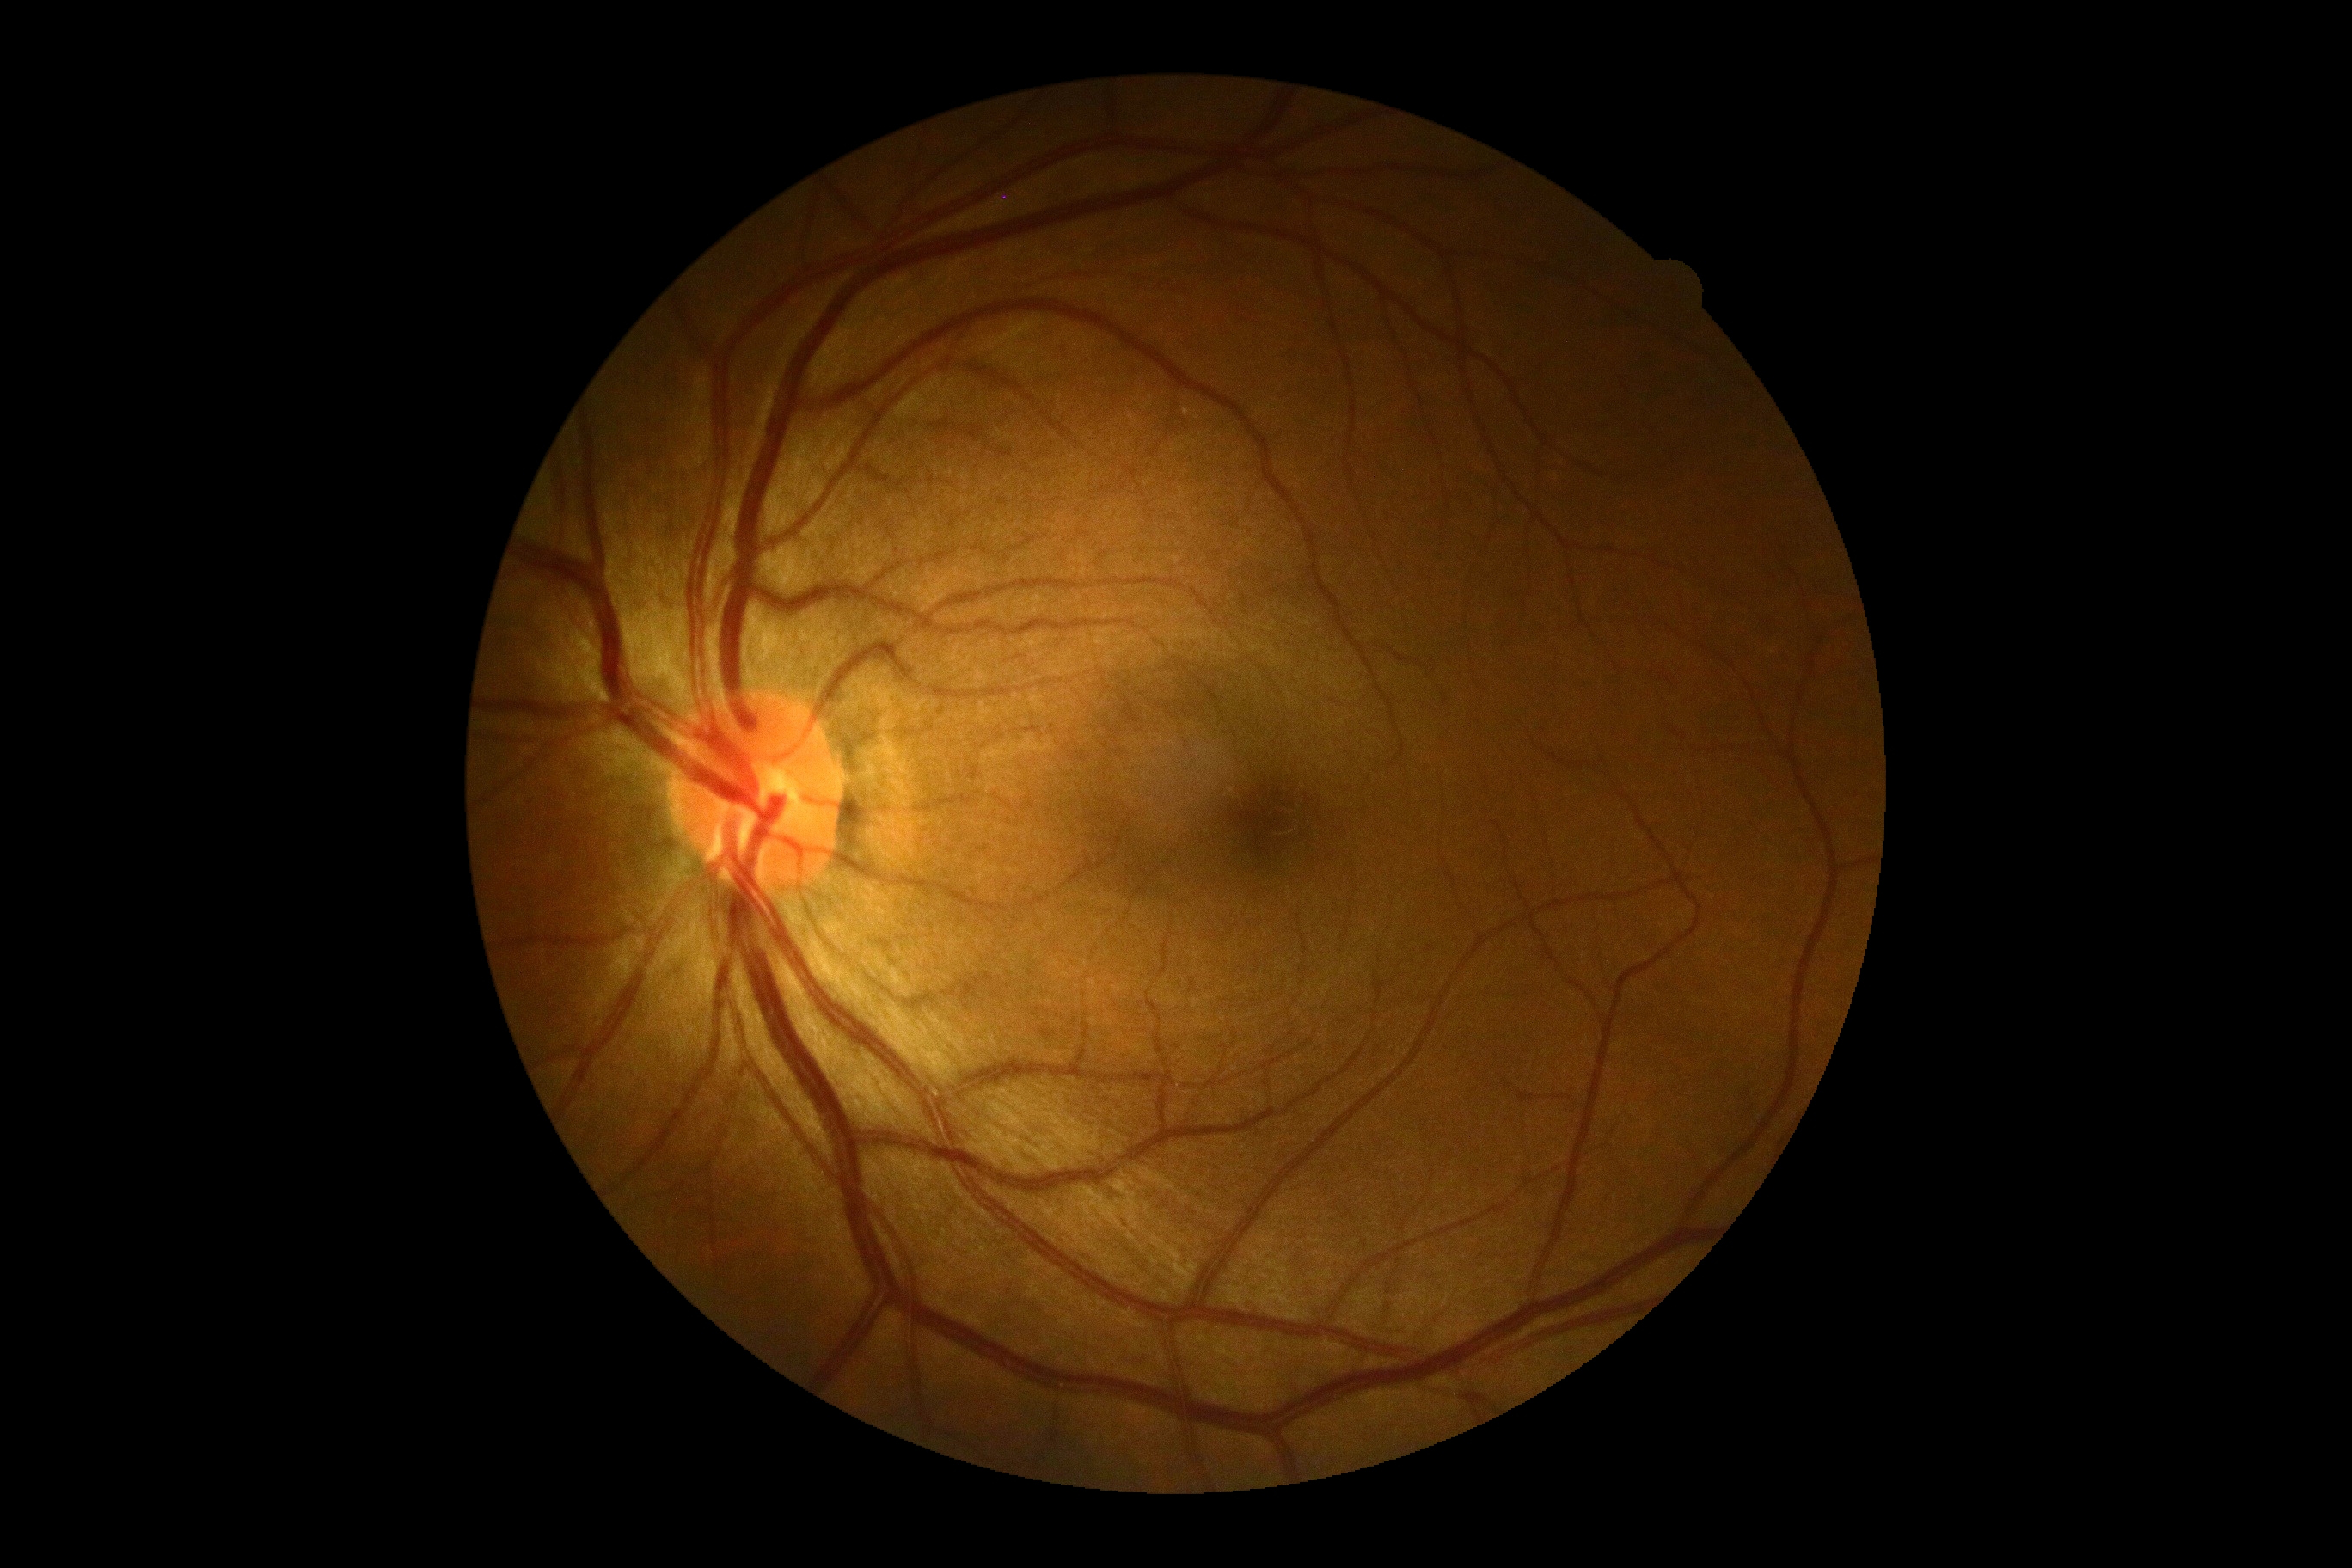 DR grade is 0.